Wide-field retinal mosaic image: 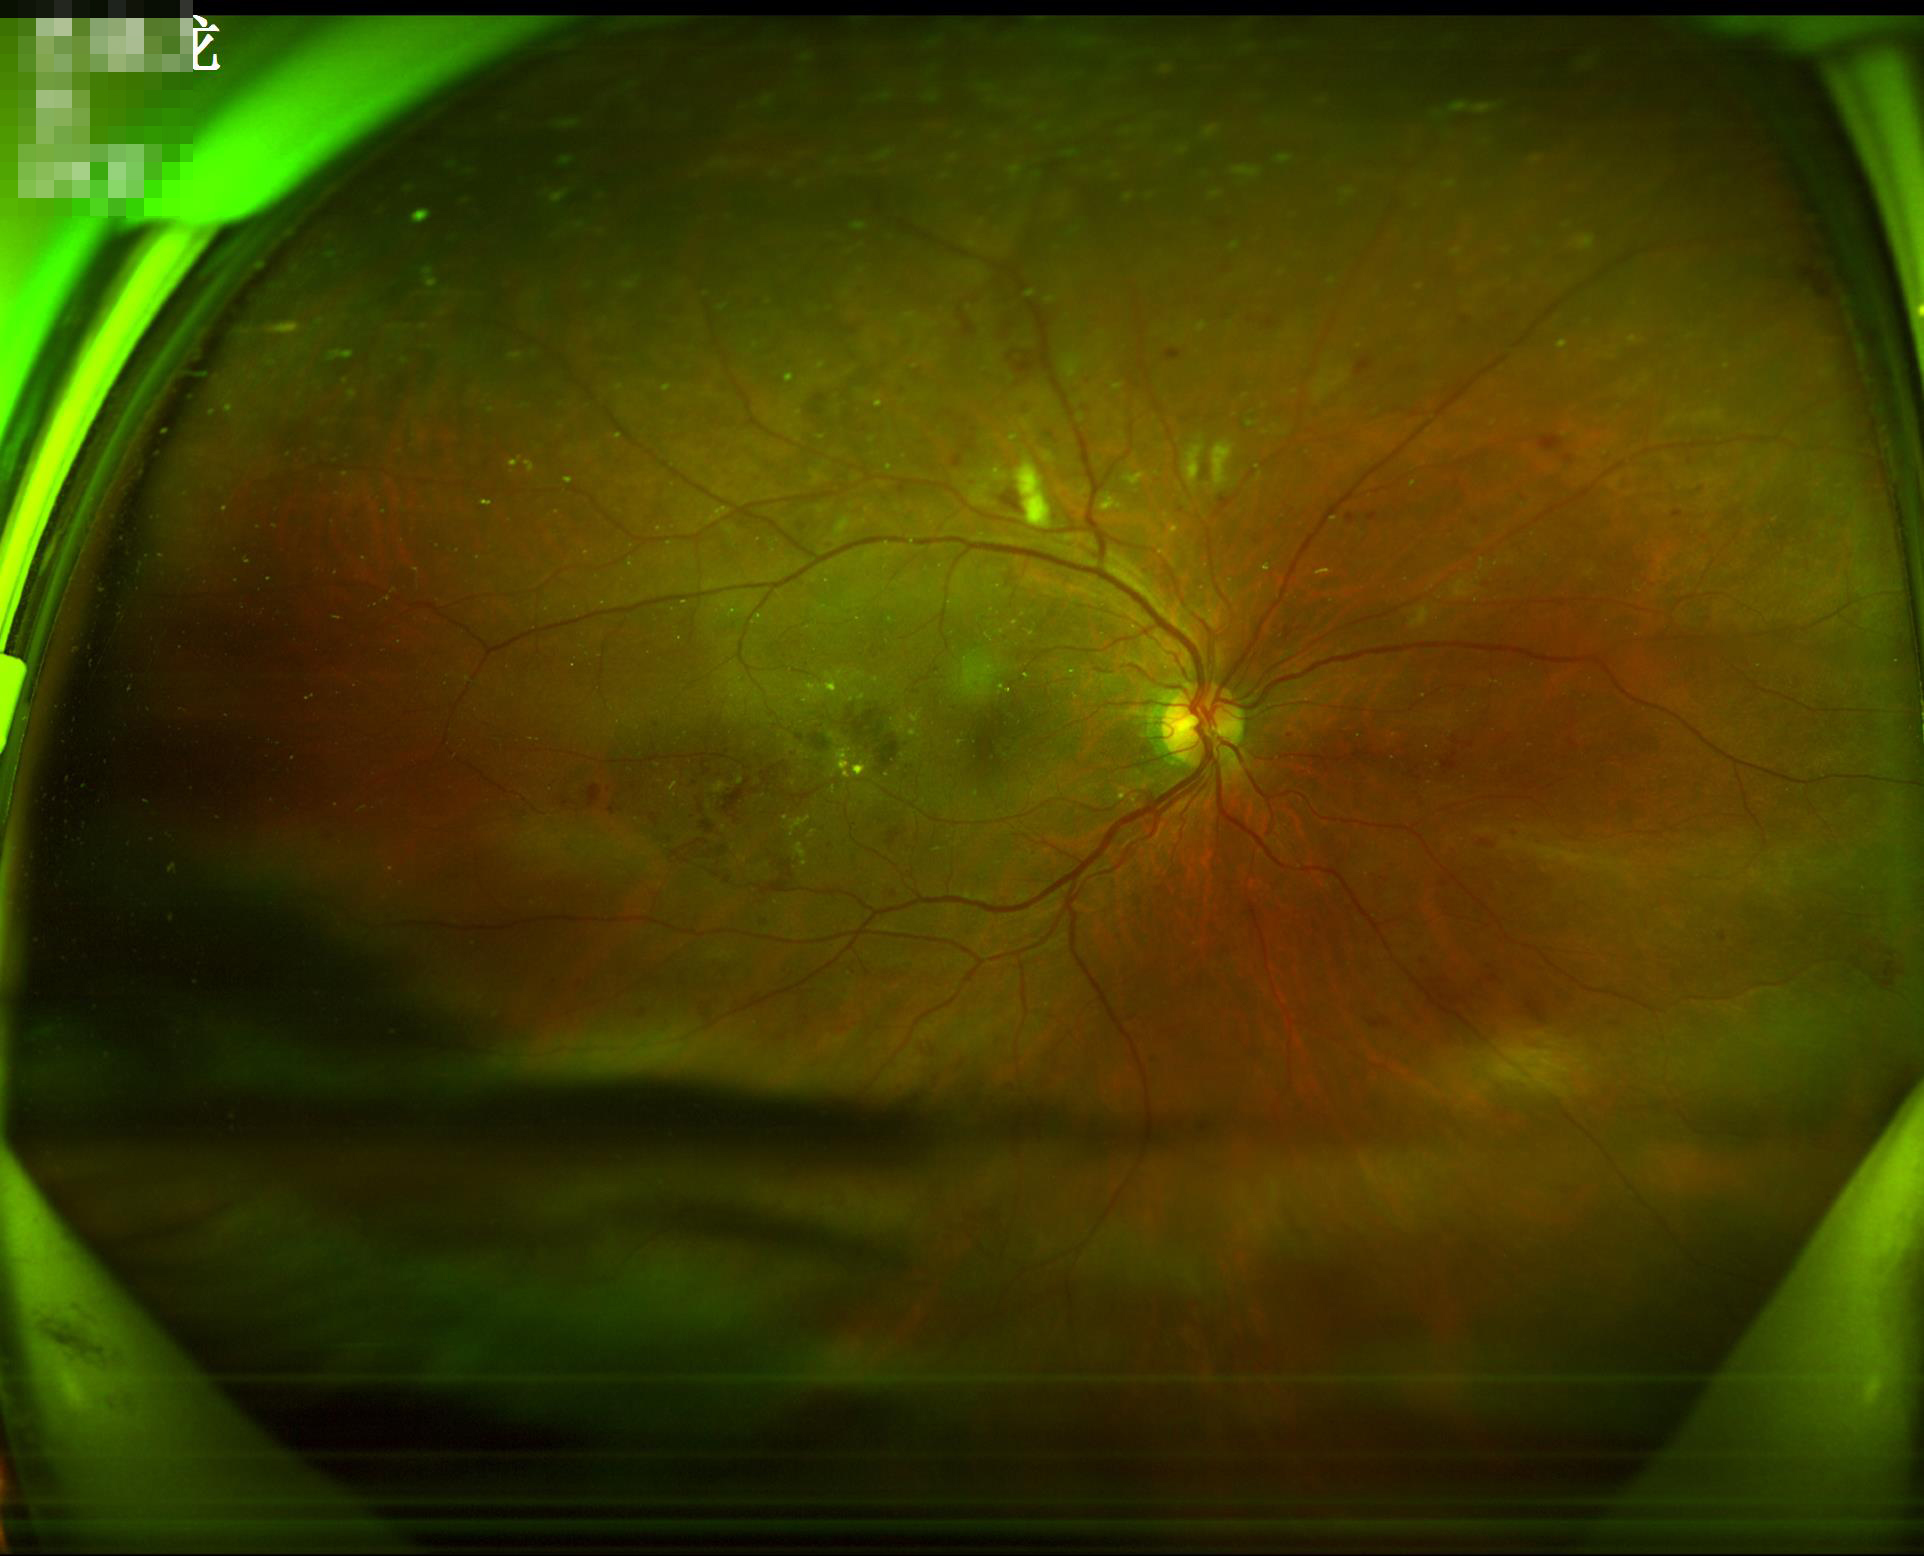

Image quality: contrast: adequate | sharpness: good | illumination/color: uneven | overall: adequate.